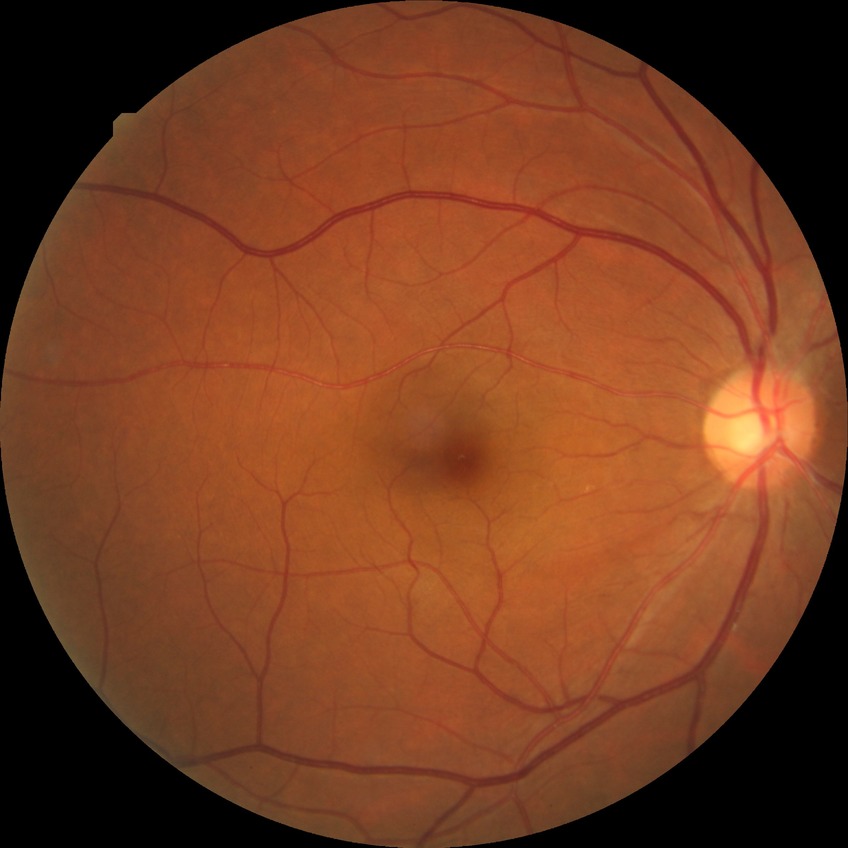
diabetic retinopathy (DR): no diabetic retinopathy (NDR).